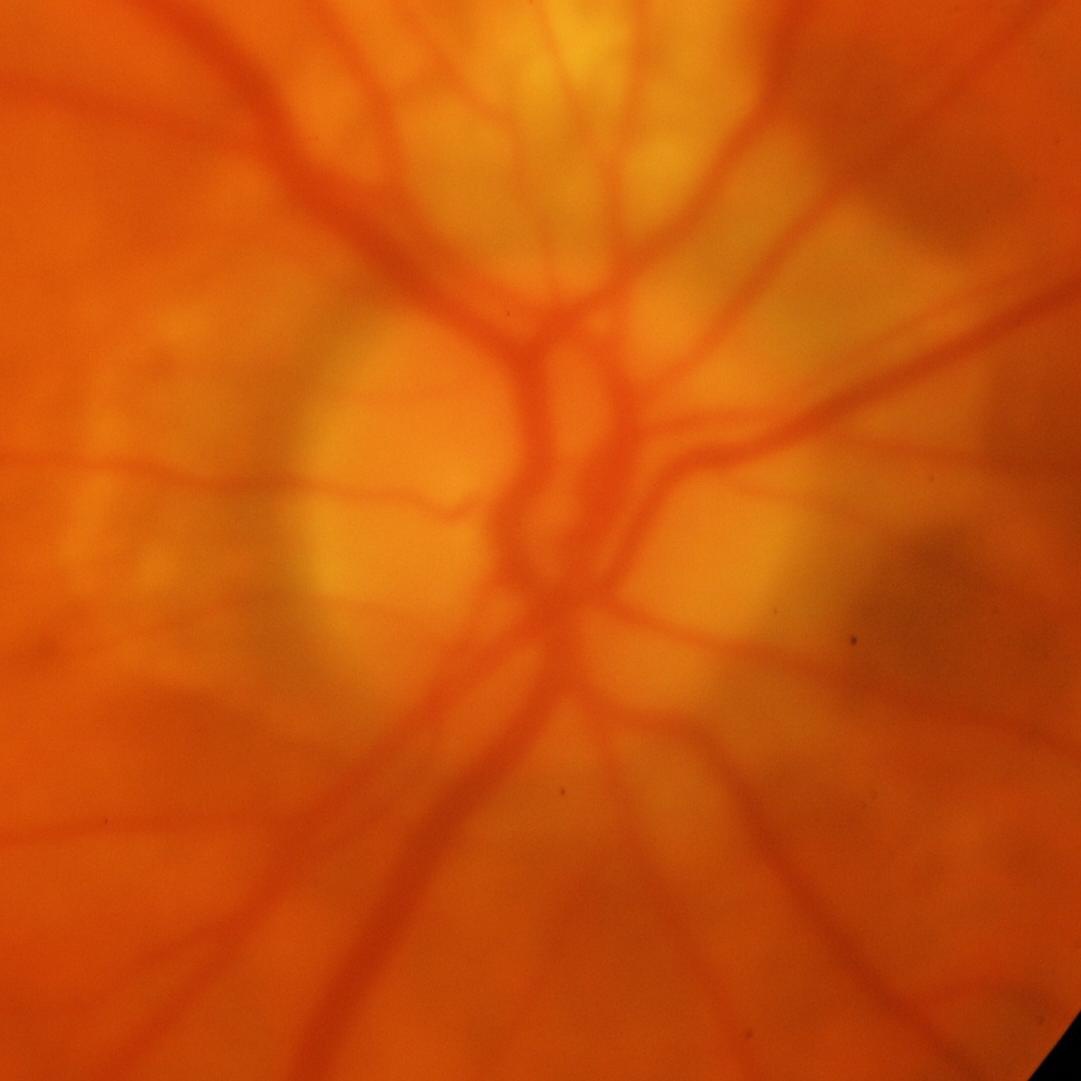 Q: Does this eye have glaucoma?
A: Glaucomatous changes.